Topcon TRC-50DX · field includes the optic disc and macula · 2228x1652px
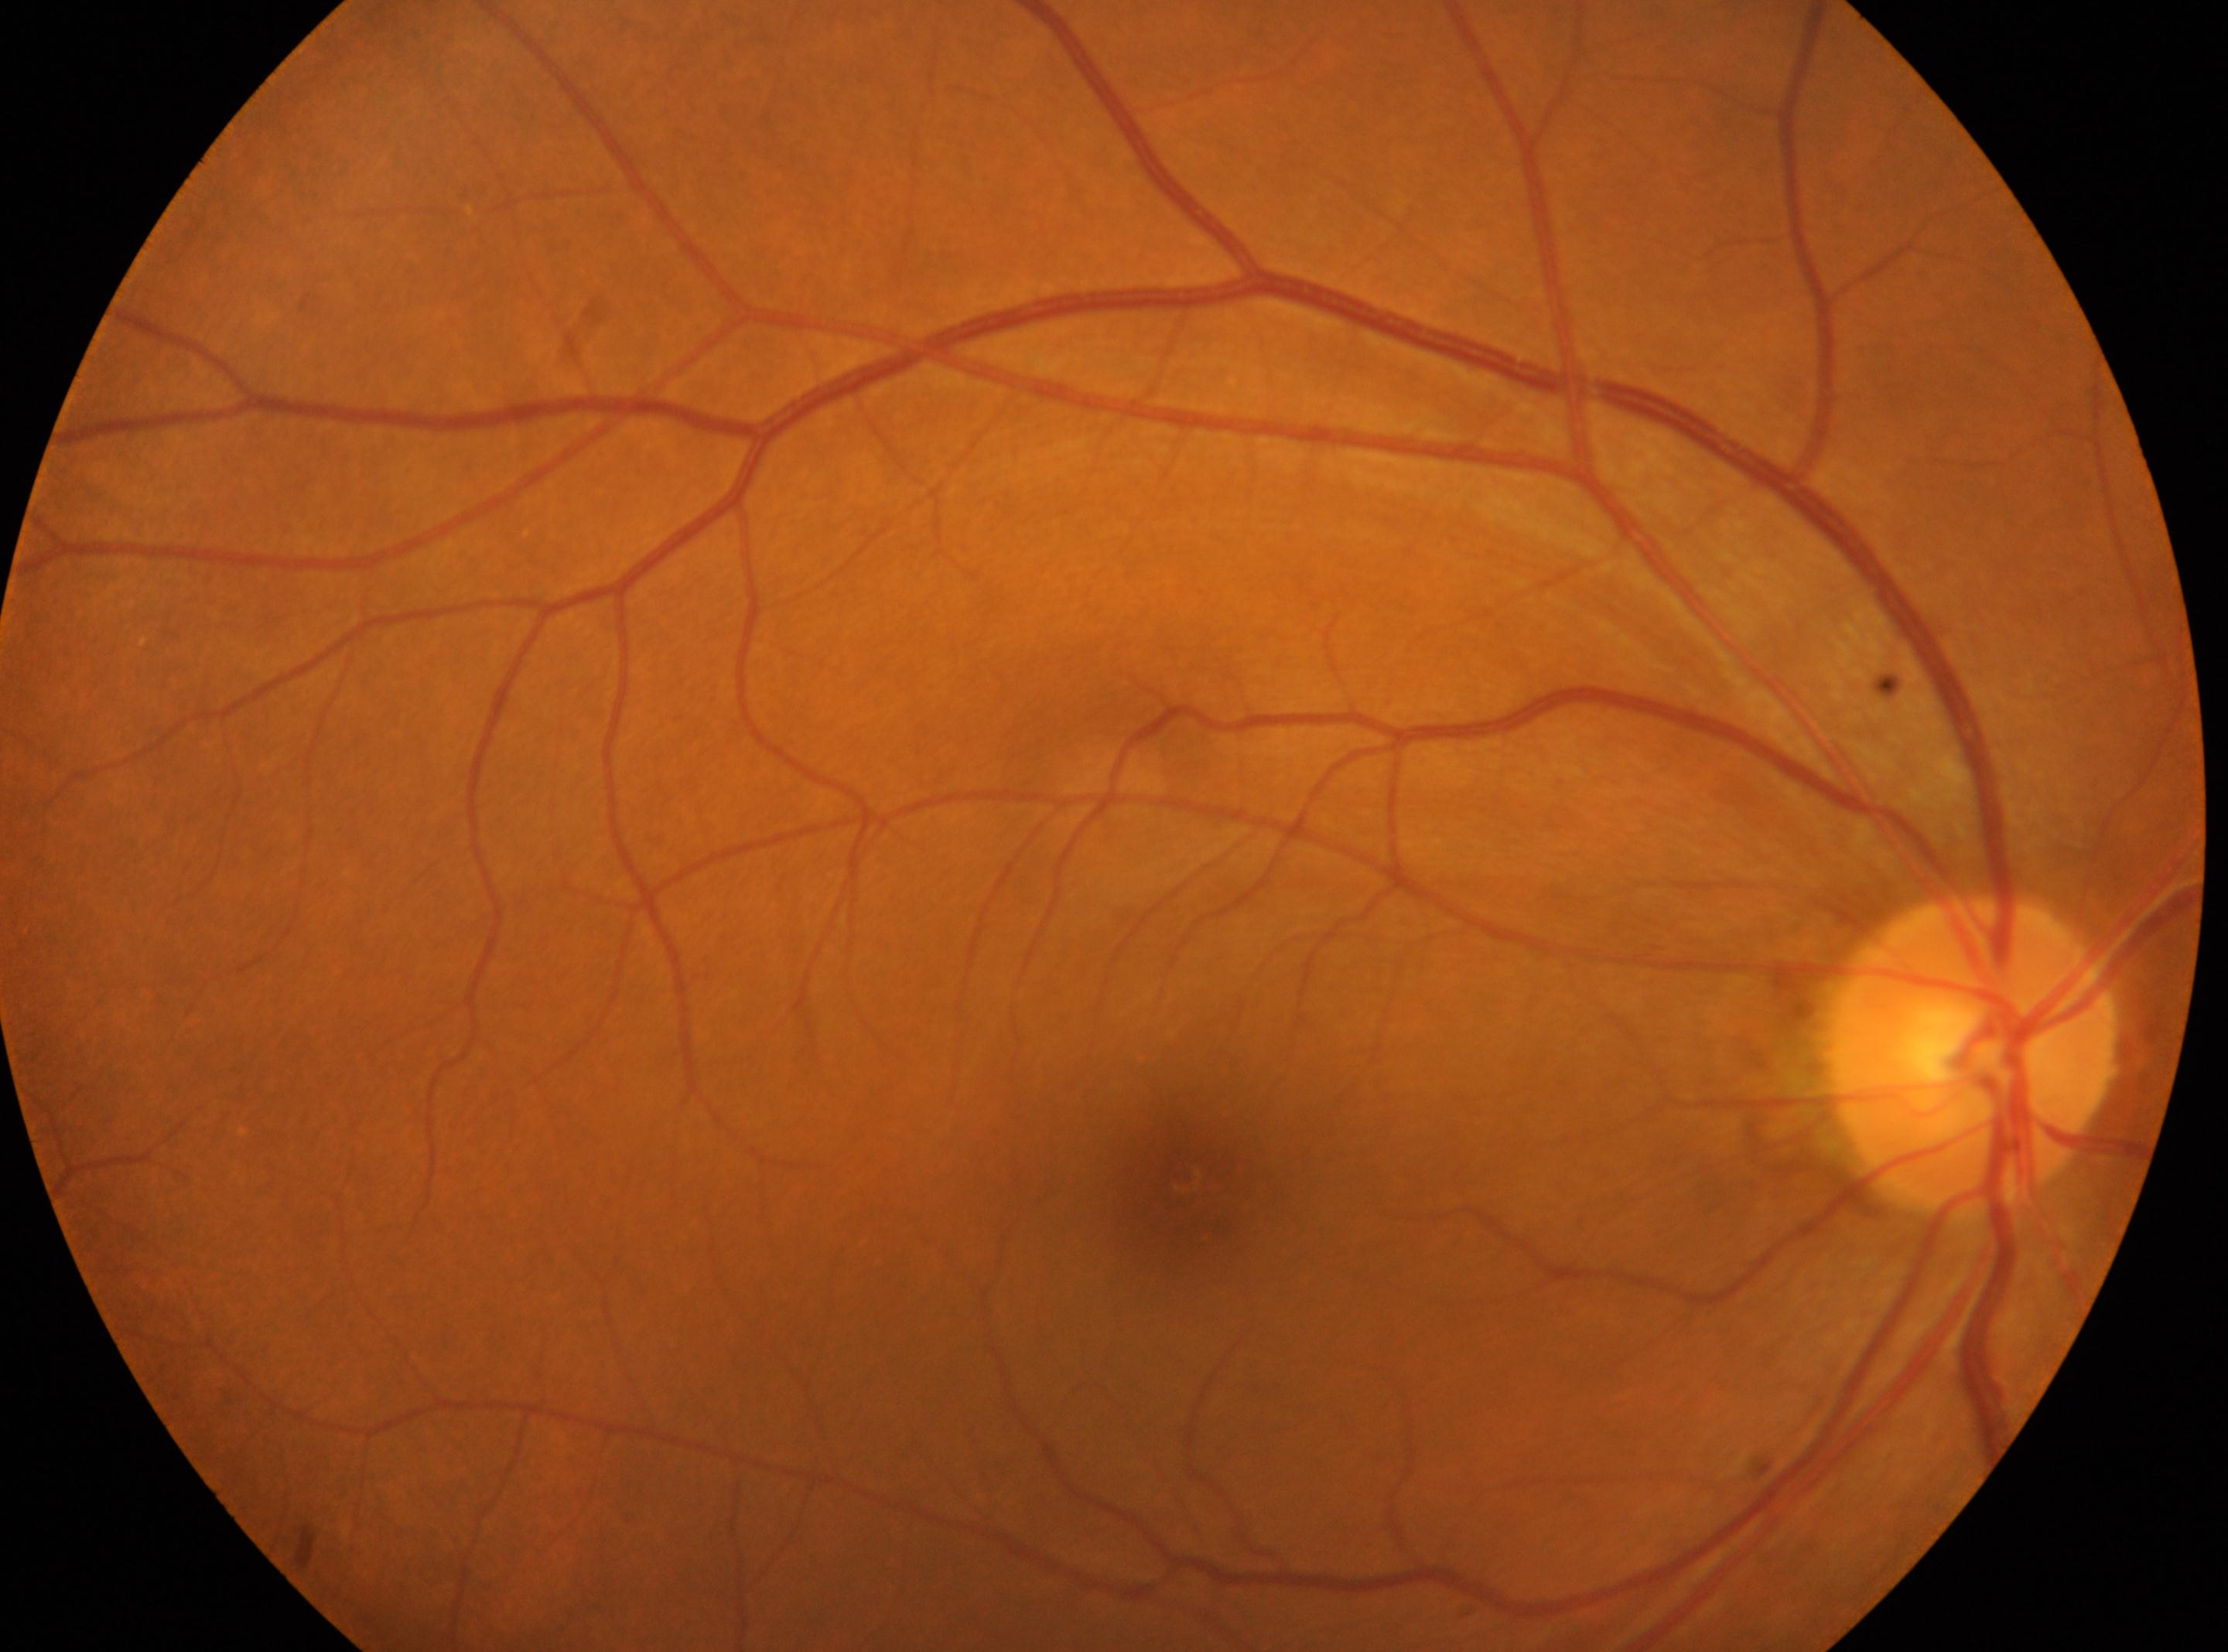 ONH: (1970, 1055). No signs of diabetic retinopathy. Fovea centralis: (1190, 1193). Eye: OD. Diabetic retinopathy: no apparent retinopathy (grade 0) — no visible signs of diabetic retinopathy.